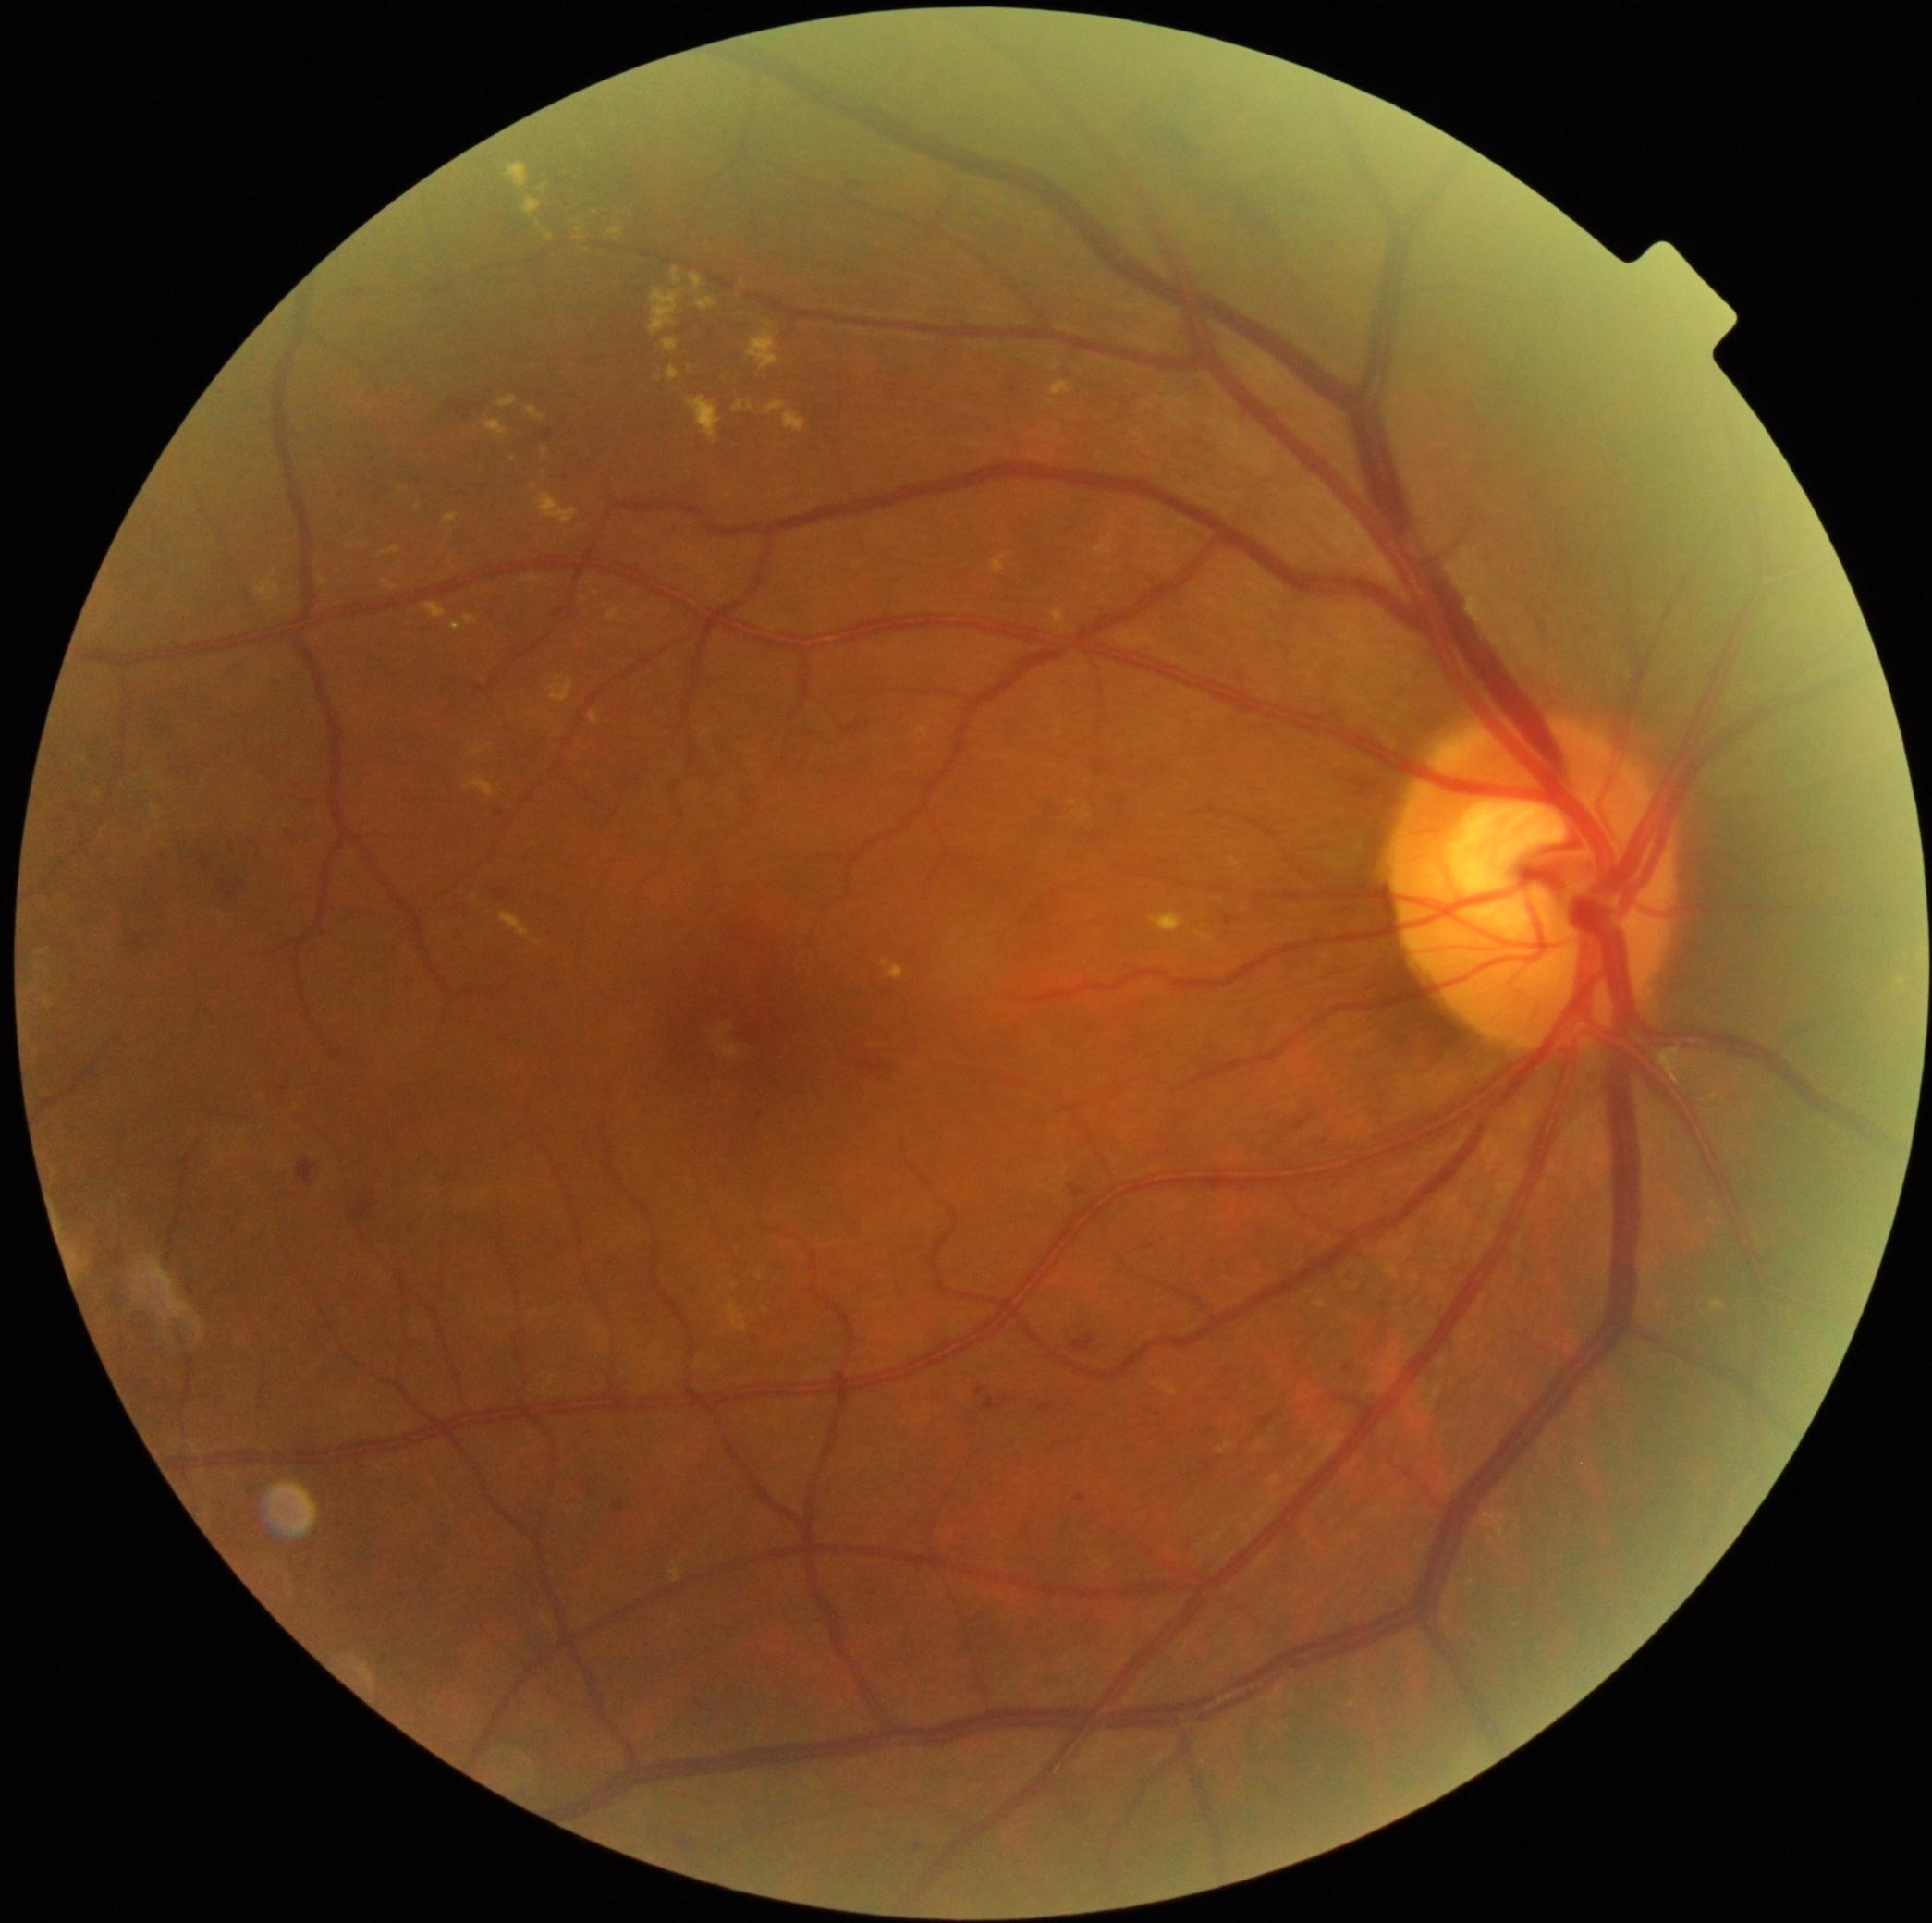 partial: true
dr_grade: 2
dr_grade_name: moderate NPDR
lesions:
  ex:
    - [x1=734, y1=401, x2=743, y2=412]
    - [x1=549, y1=677, x2=575, y2=704]
    - [x1=882, y1=961, x2=891, y2=969]
    - [x1=498, y1=396, x2=520, y2=409]
    - [x1=523, y1=198, x2=544, y2=216]
    - [x1=506, y1=164, x2=529, y2=188]
    - [x1=465, y1=615, x2=478, y2=626]
    - [x1=472, y1=746, x2=493, y2=757]
    - [x1=889, y1=966, x2=905, y2=982]
    - [x1=1709, y1=1302, x2=1726, y2=1313]
    - [x1=688, y1=398, x2=721, y2=445]
  ex_small_approx:
    - 539, 225
    - 587, 251
    - 707, 733
    - 274, 574
    - 765, 1312
    - 580, 238
    - 1110, 573